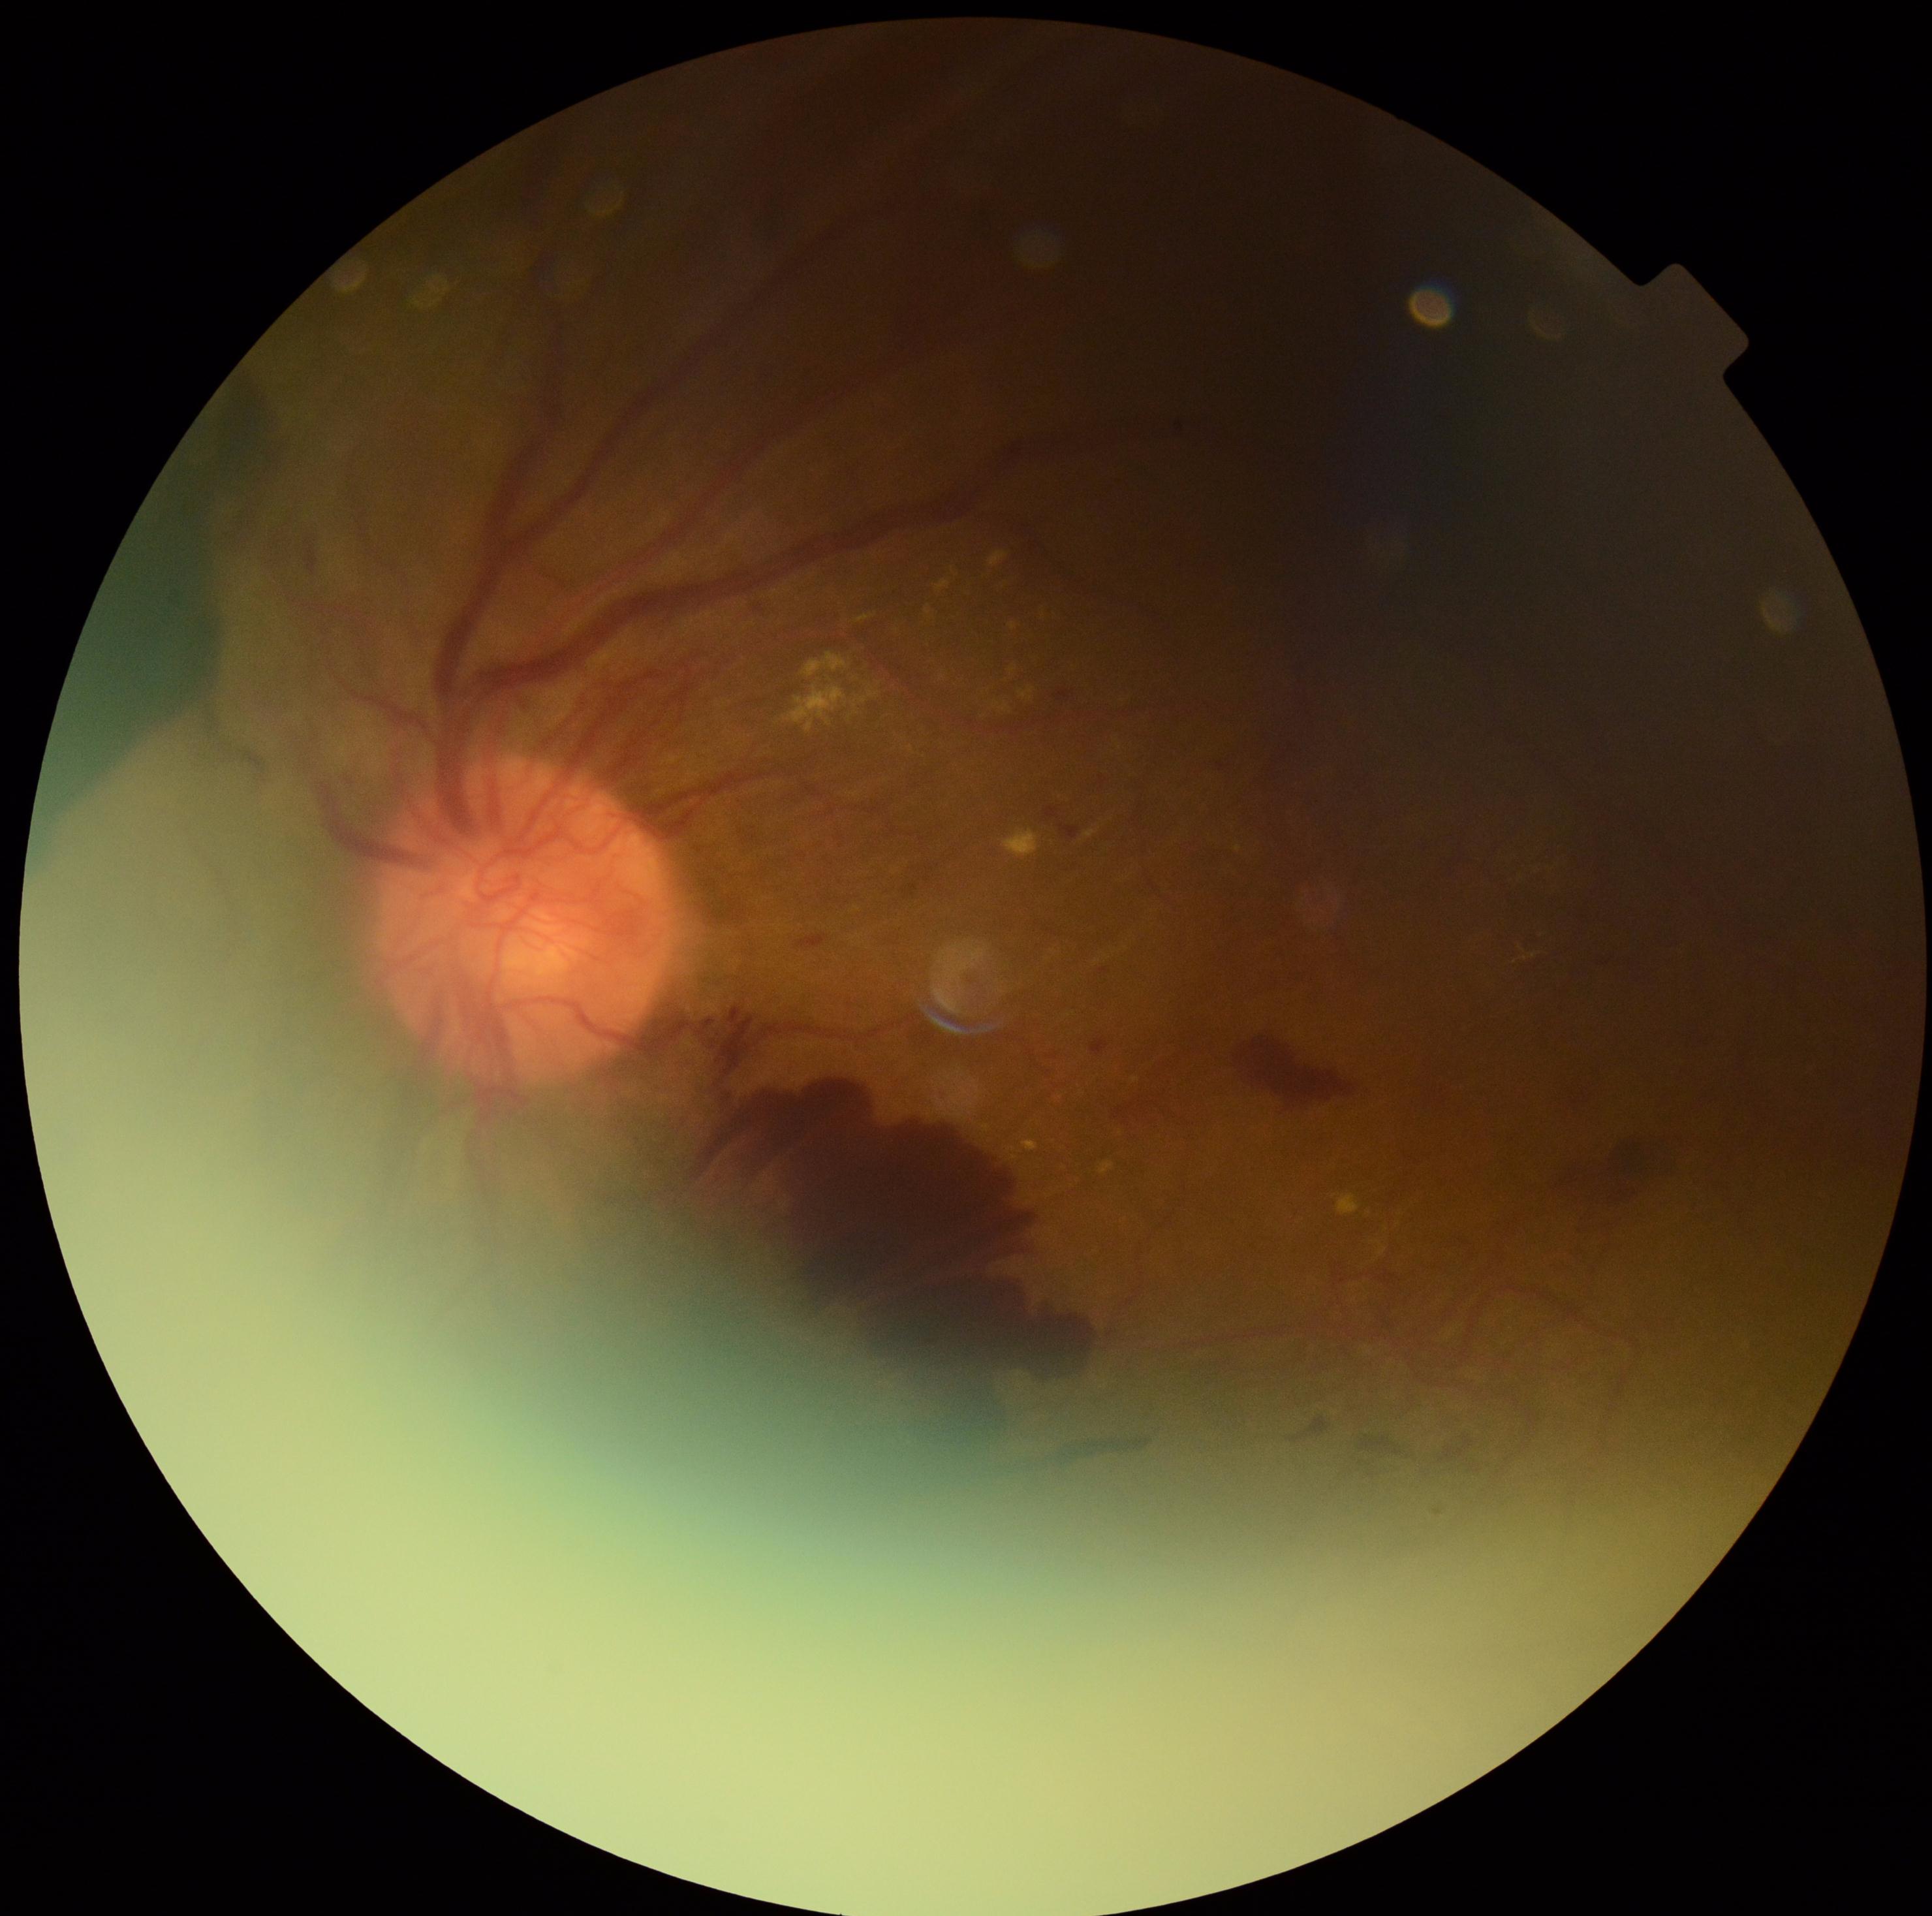 Findings:
– diabetic retinopathy (DR) — PDR (grade 4)